2212 x 1659 pixels · FOV: 45 degrees · retinal fundus photograph — 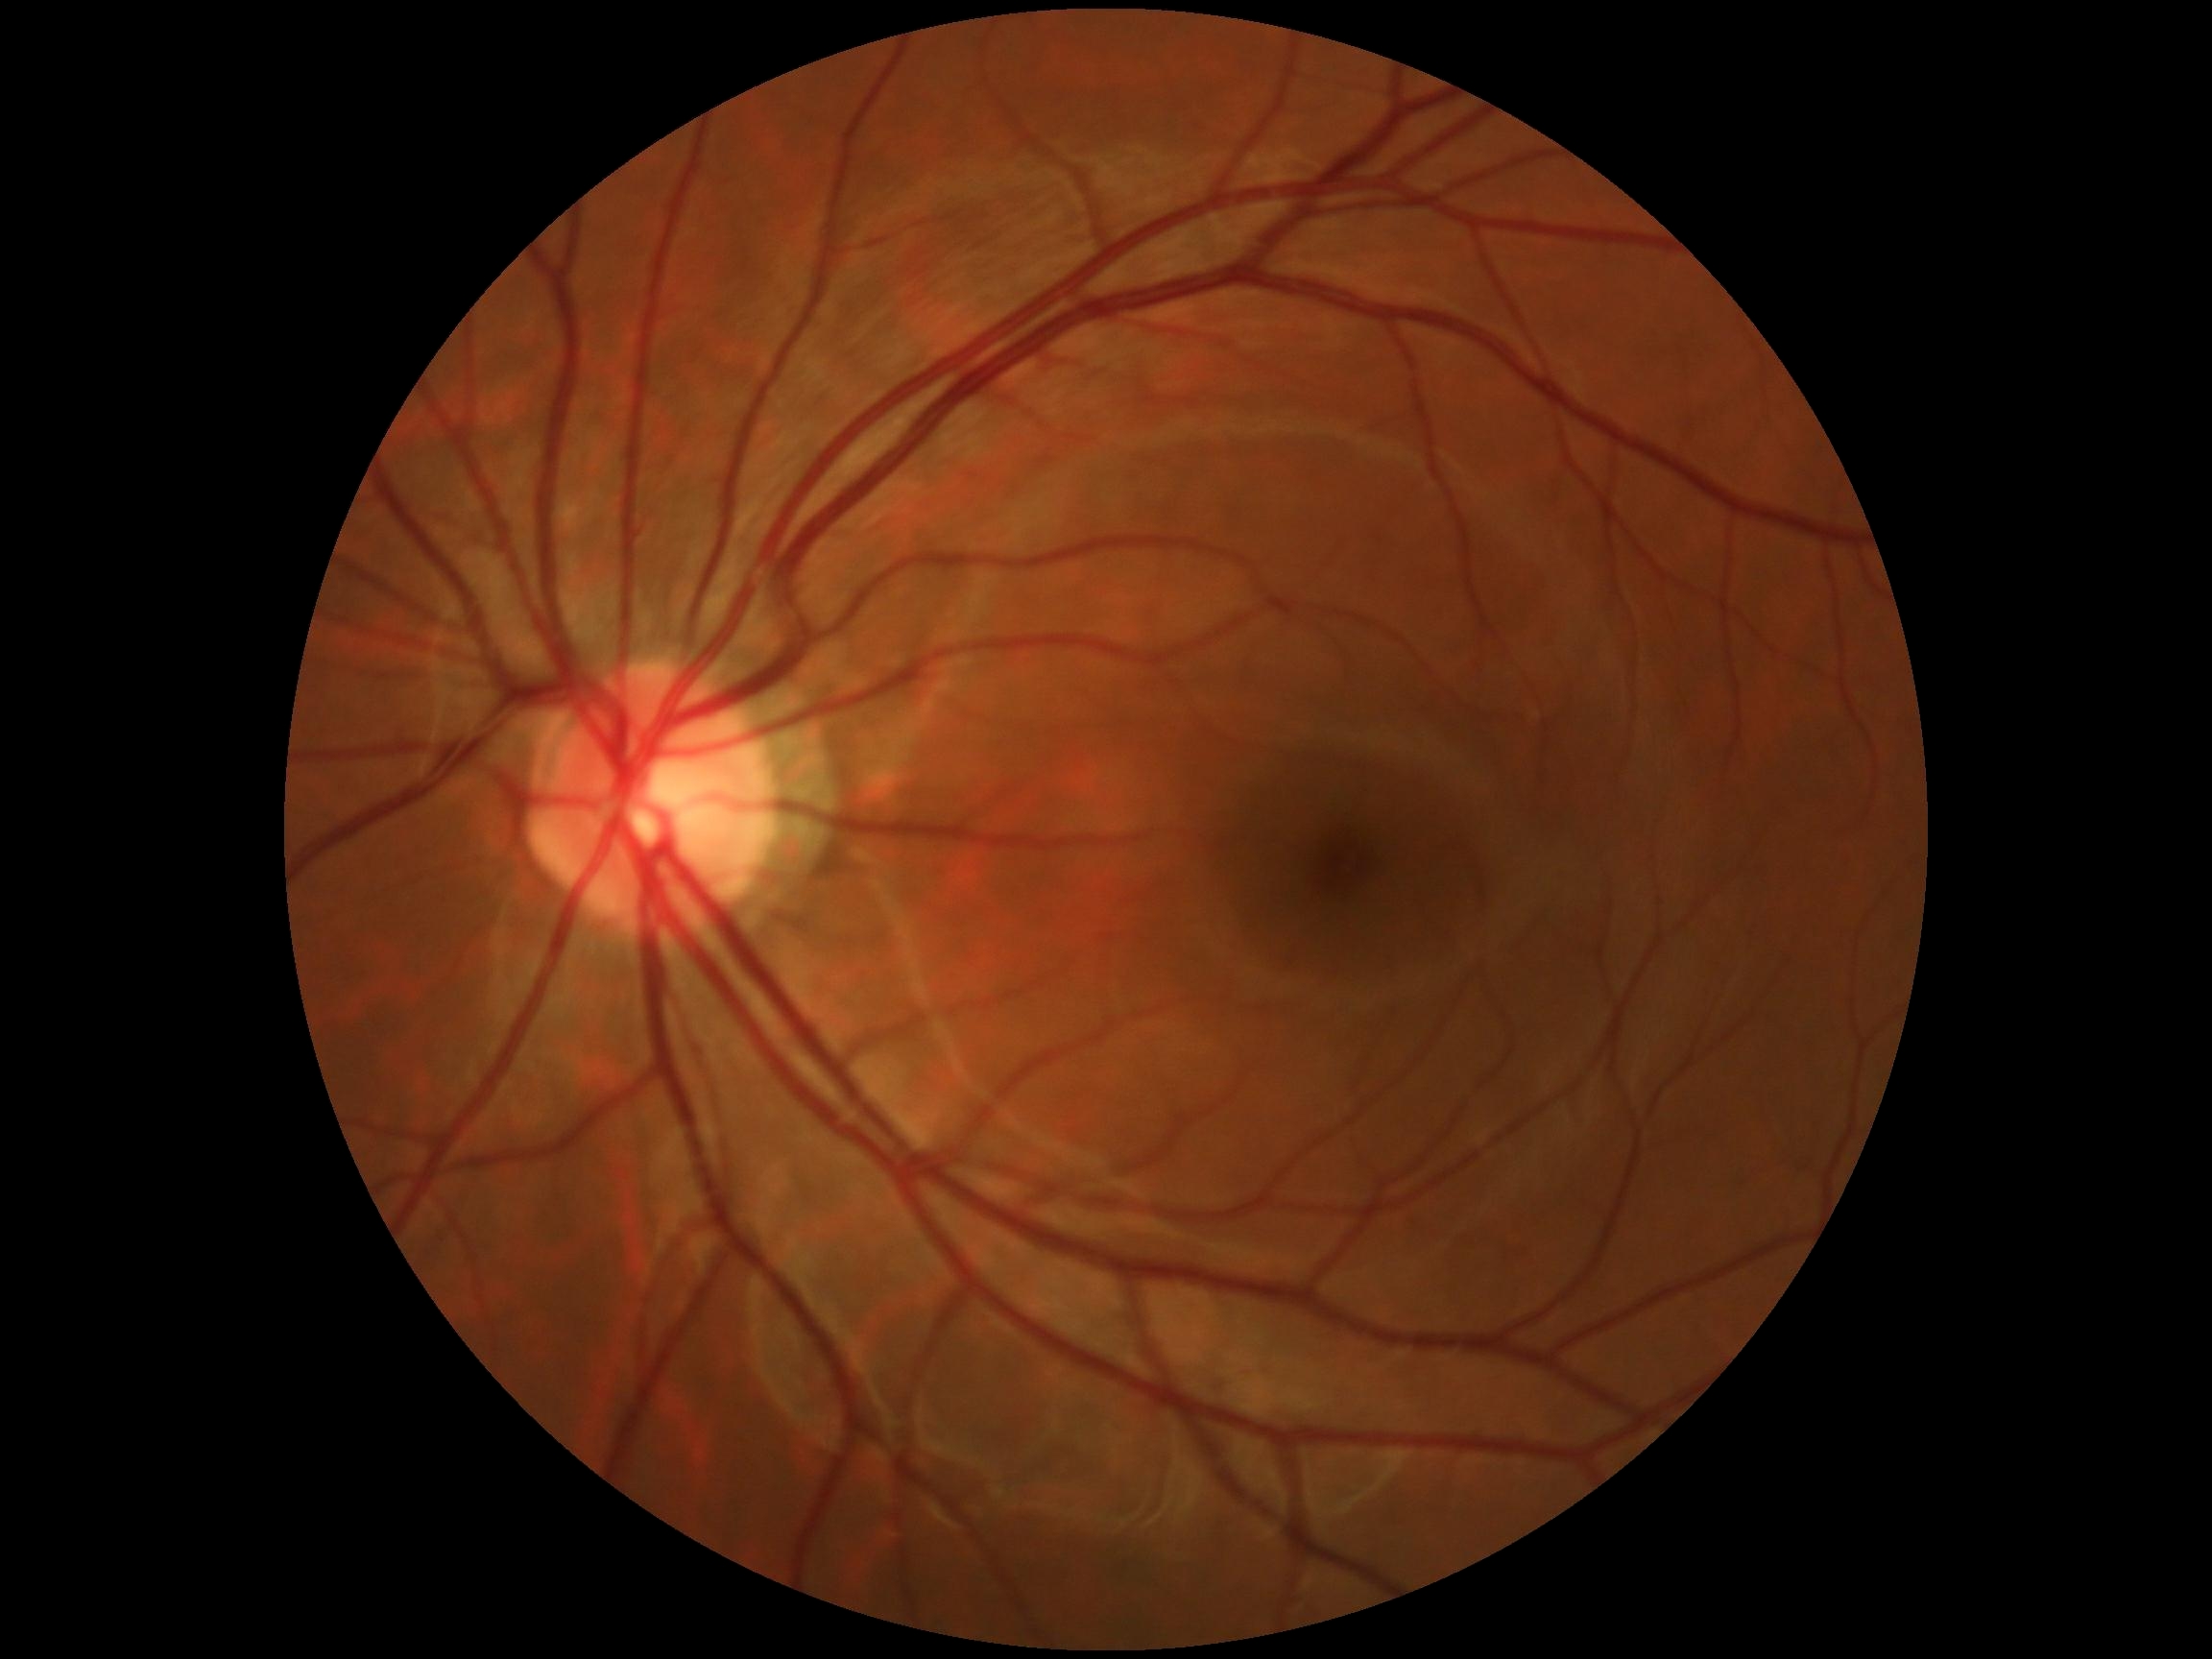 Retinopathy grade is 0 (no apparent retinopathy).
No signs of diabetic retinopathy.